45° FOV.
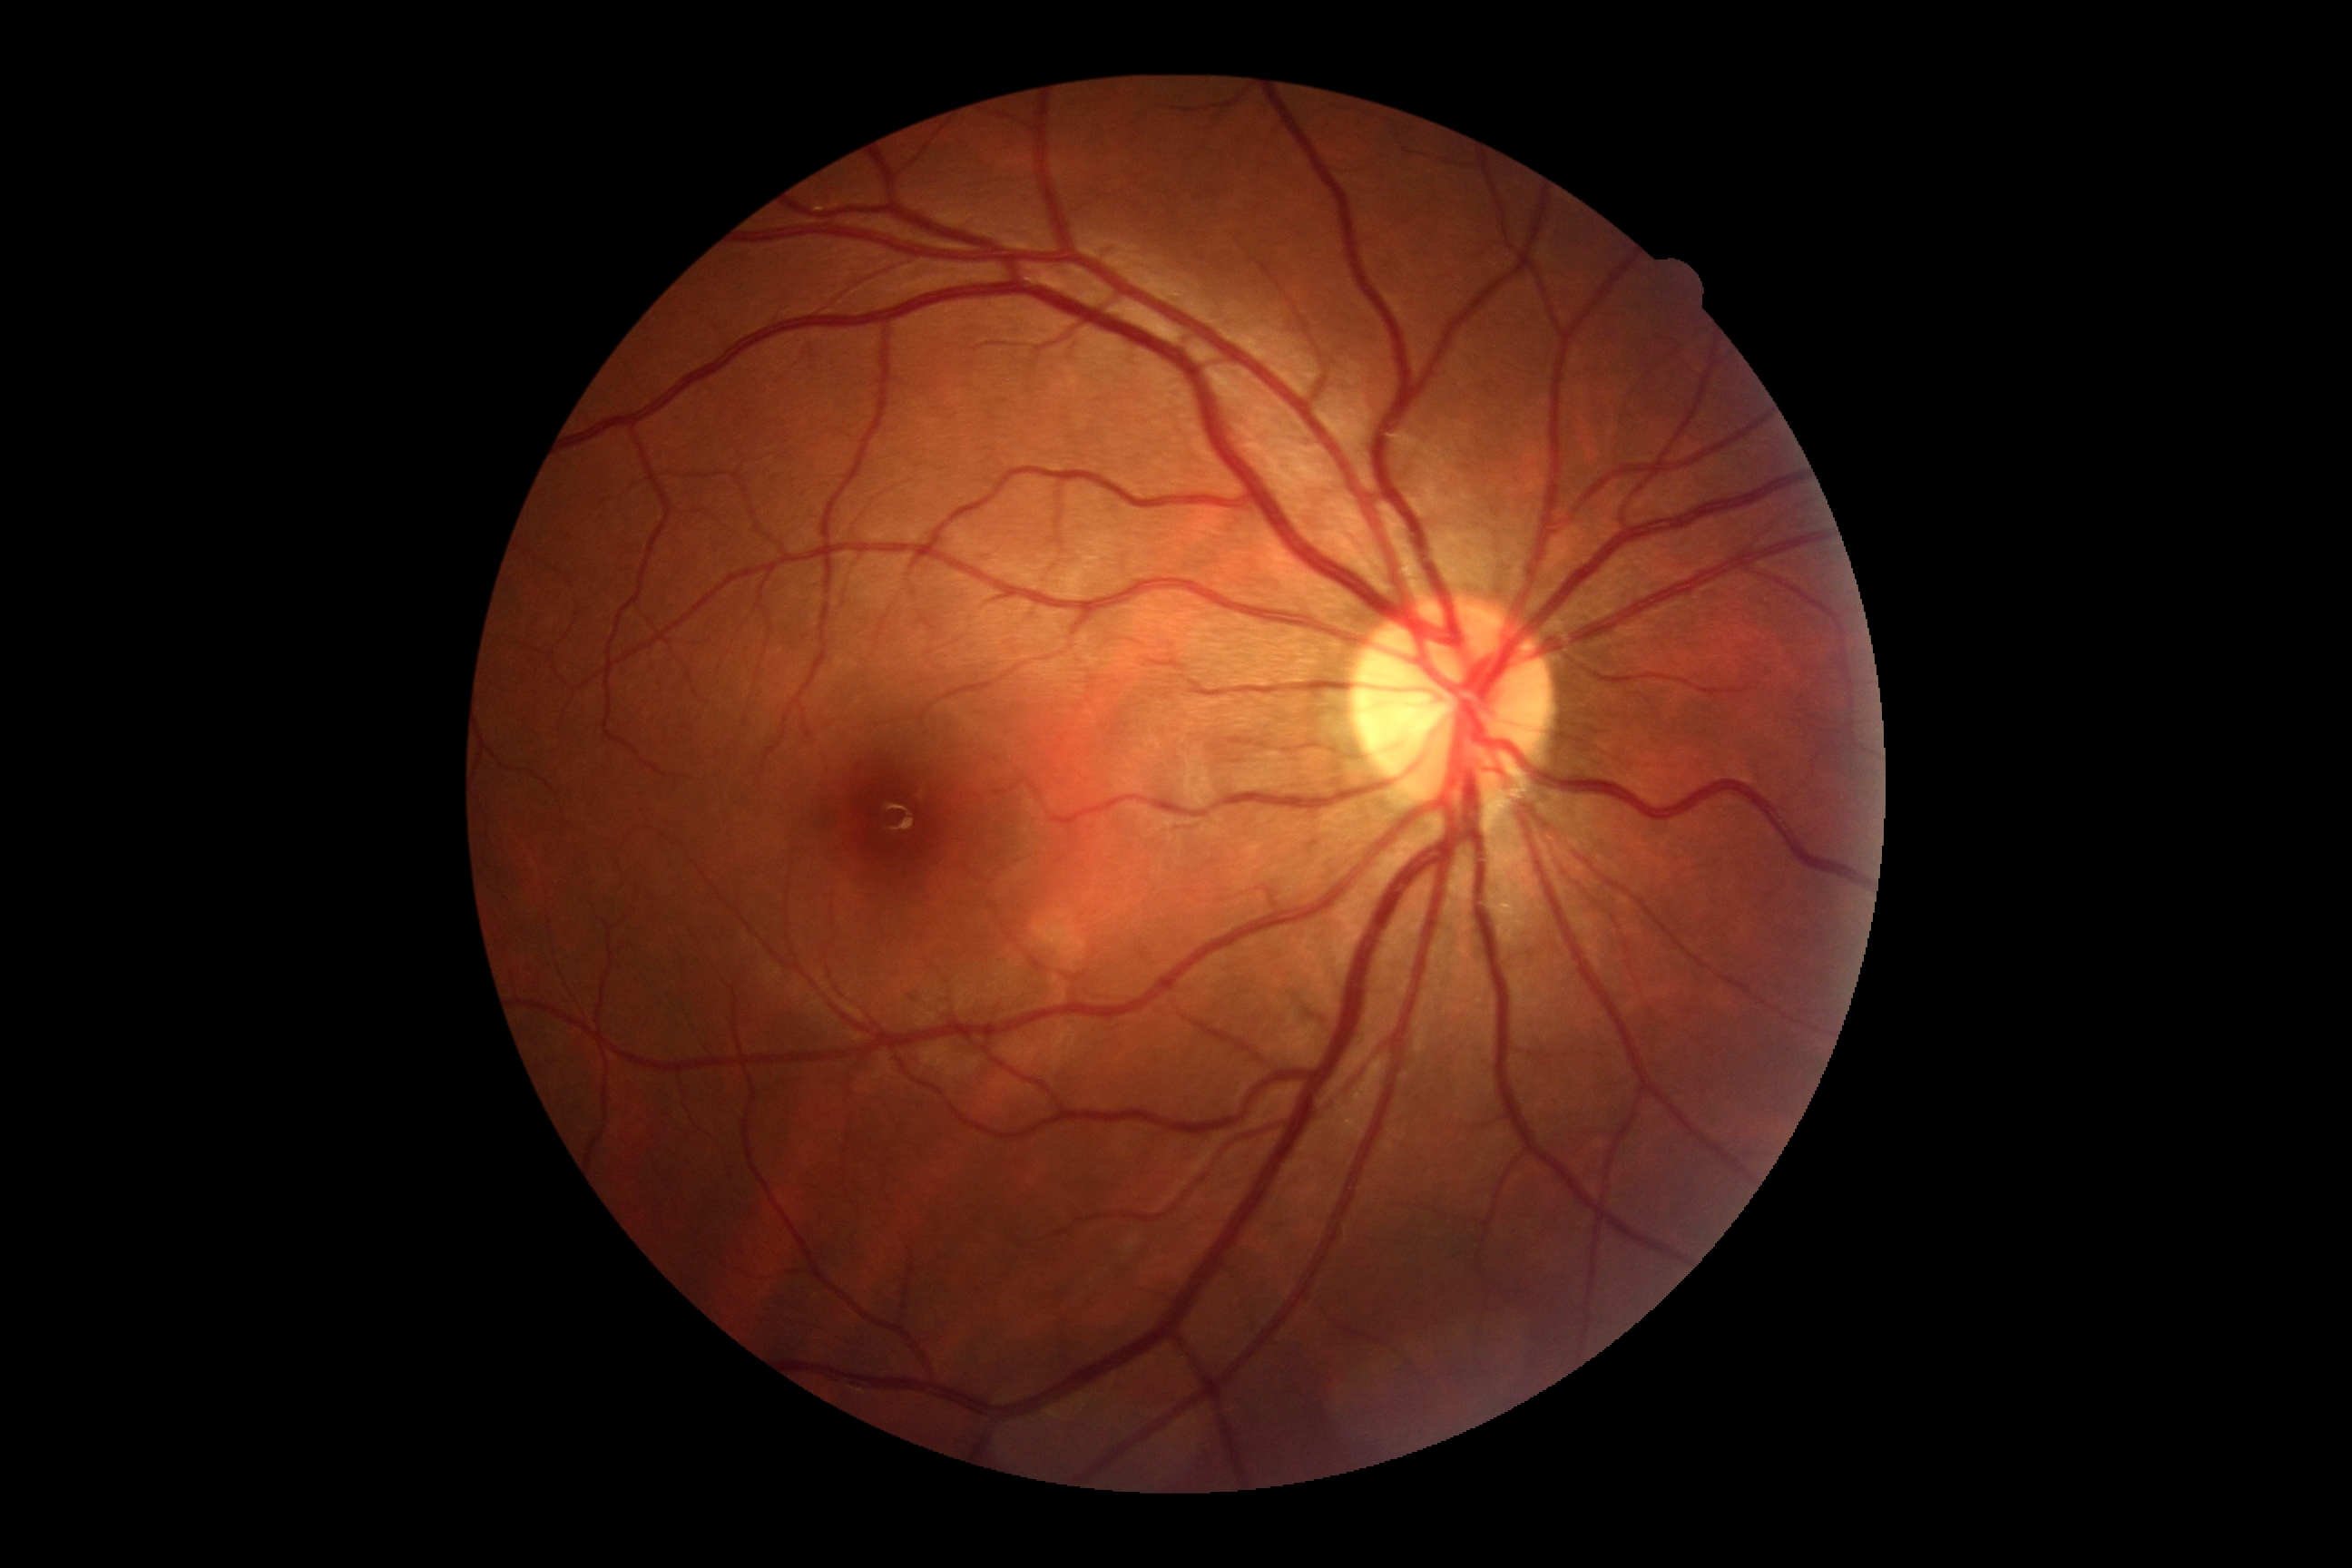

DR severity: no apparent diabetic retinopathy (grade 0).